2048x1536, Forus 3Nethra Classic fundus camera, color fundus photograph: 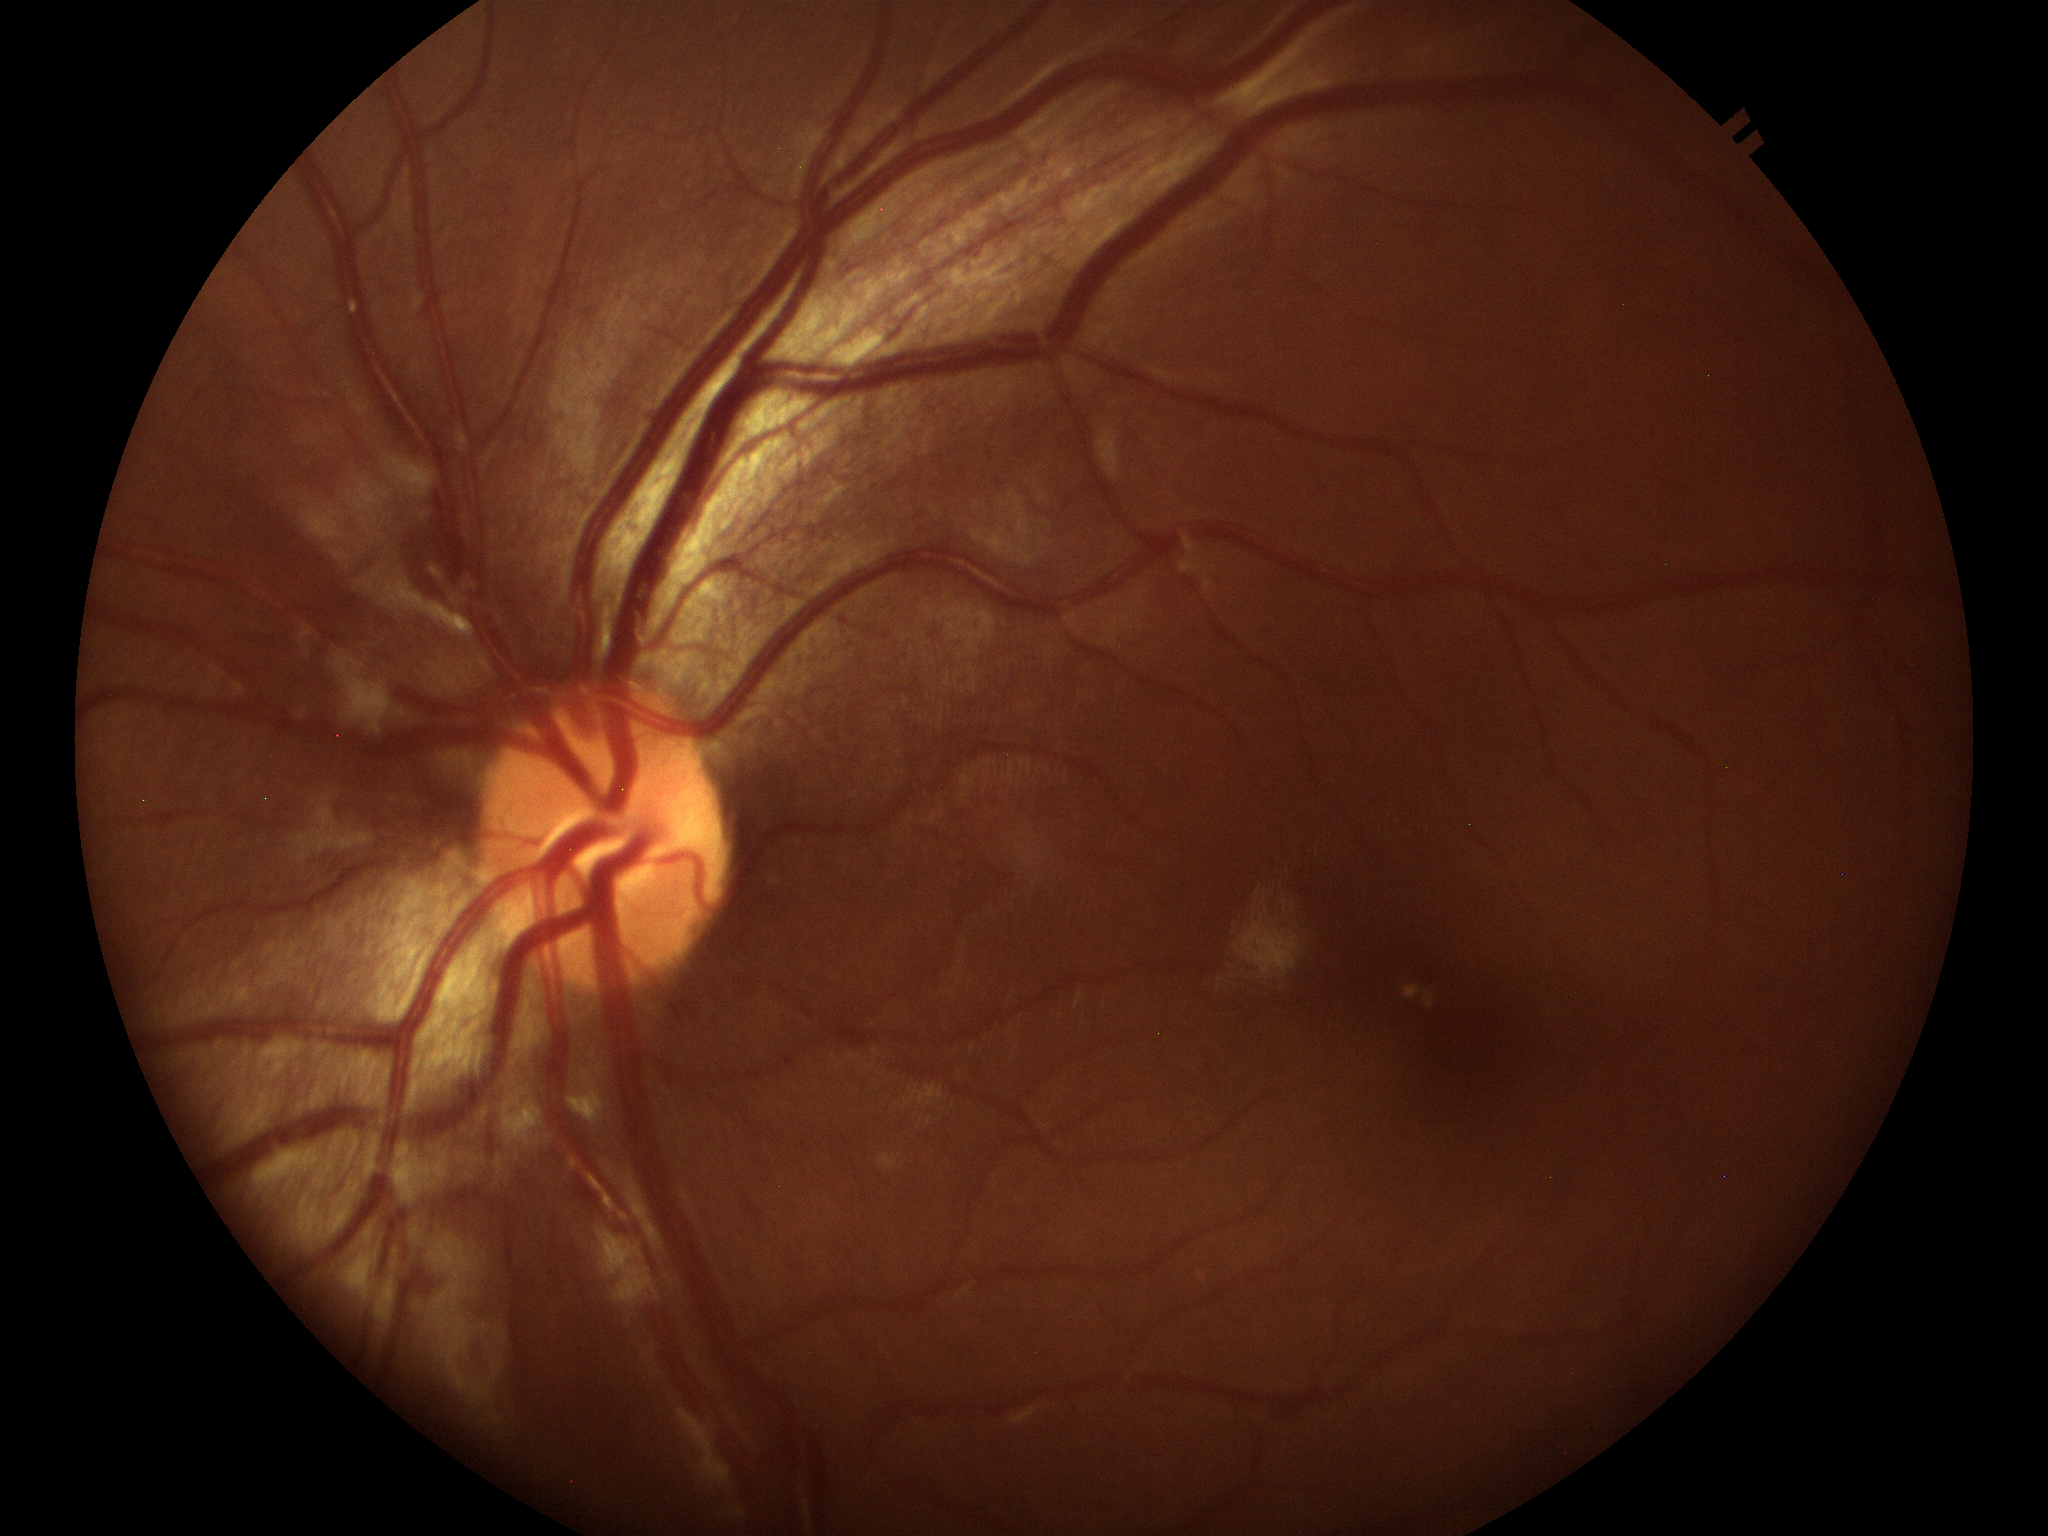
Optic disc analysis:
• Glaucoma decision: no suspicious findings
• vertical CDR (VCDR): 0.41
• area cup-to-disc ratio (ACDR): 0.19